Camera: NIDEK AFC-230 · nonmydriatic · 45-degree field of view.
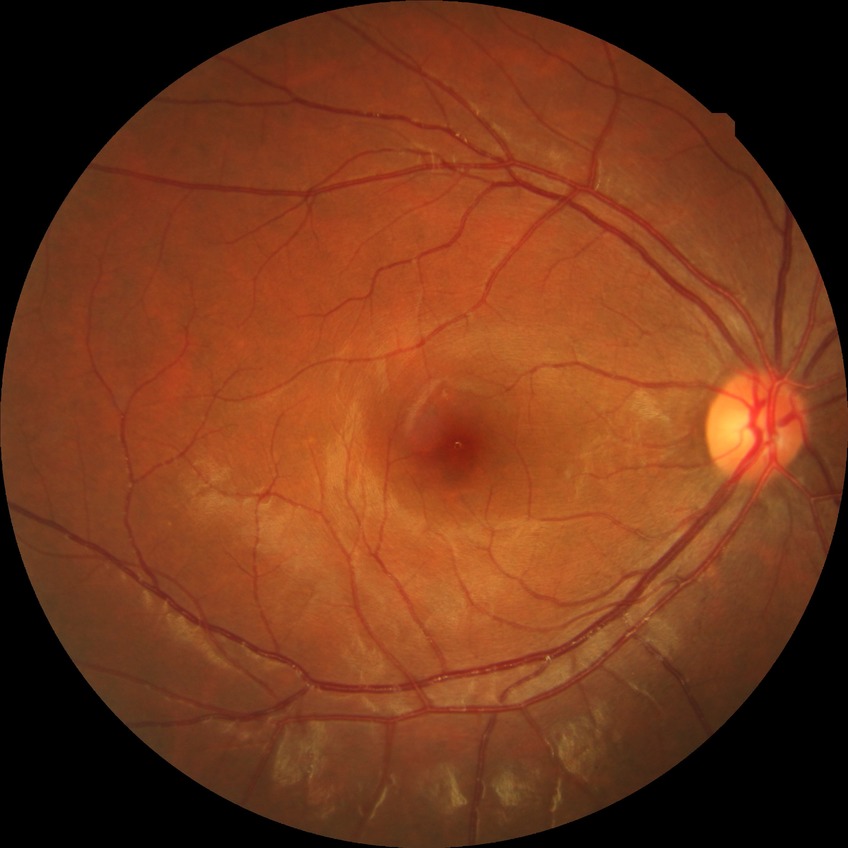 Davis DR grade: NDR.
No diabetic retinal disease findings.